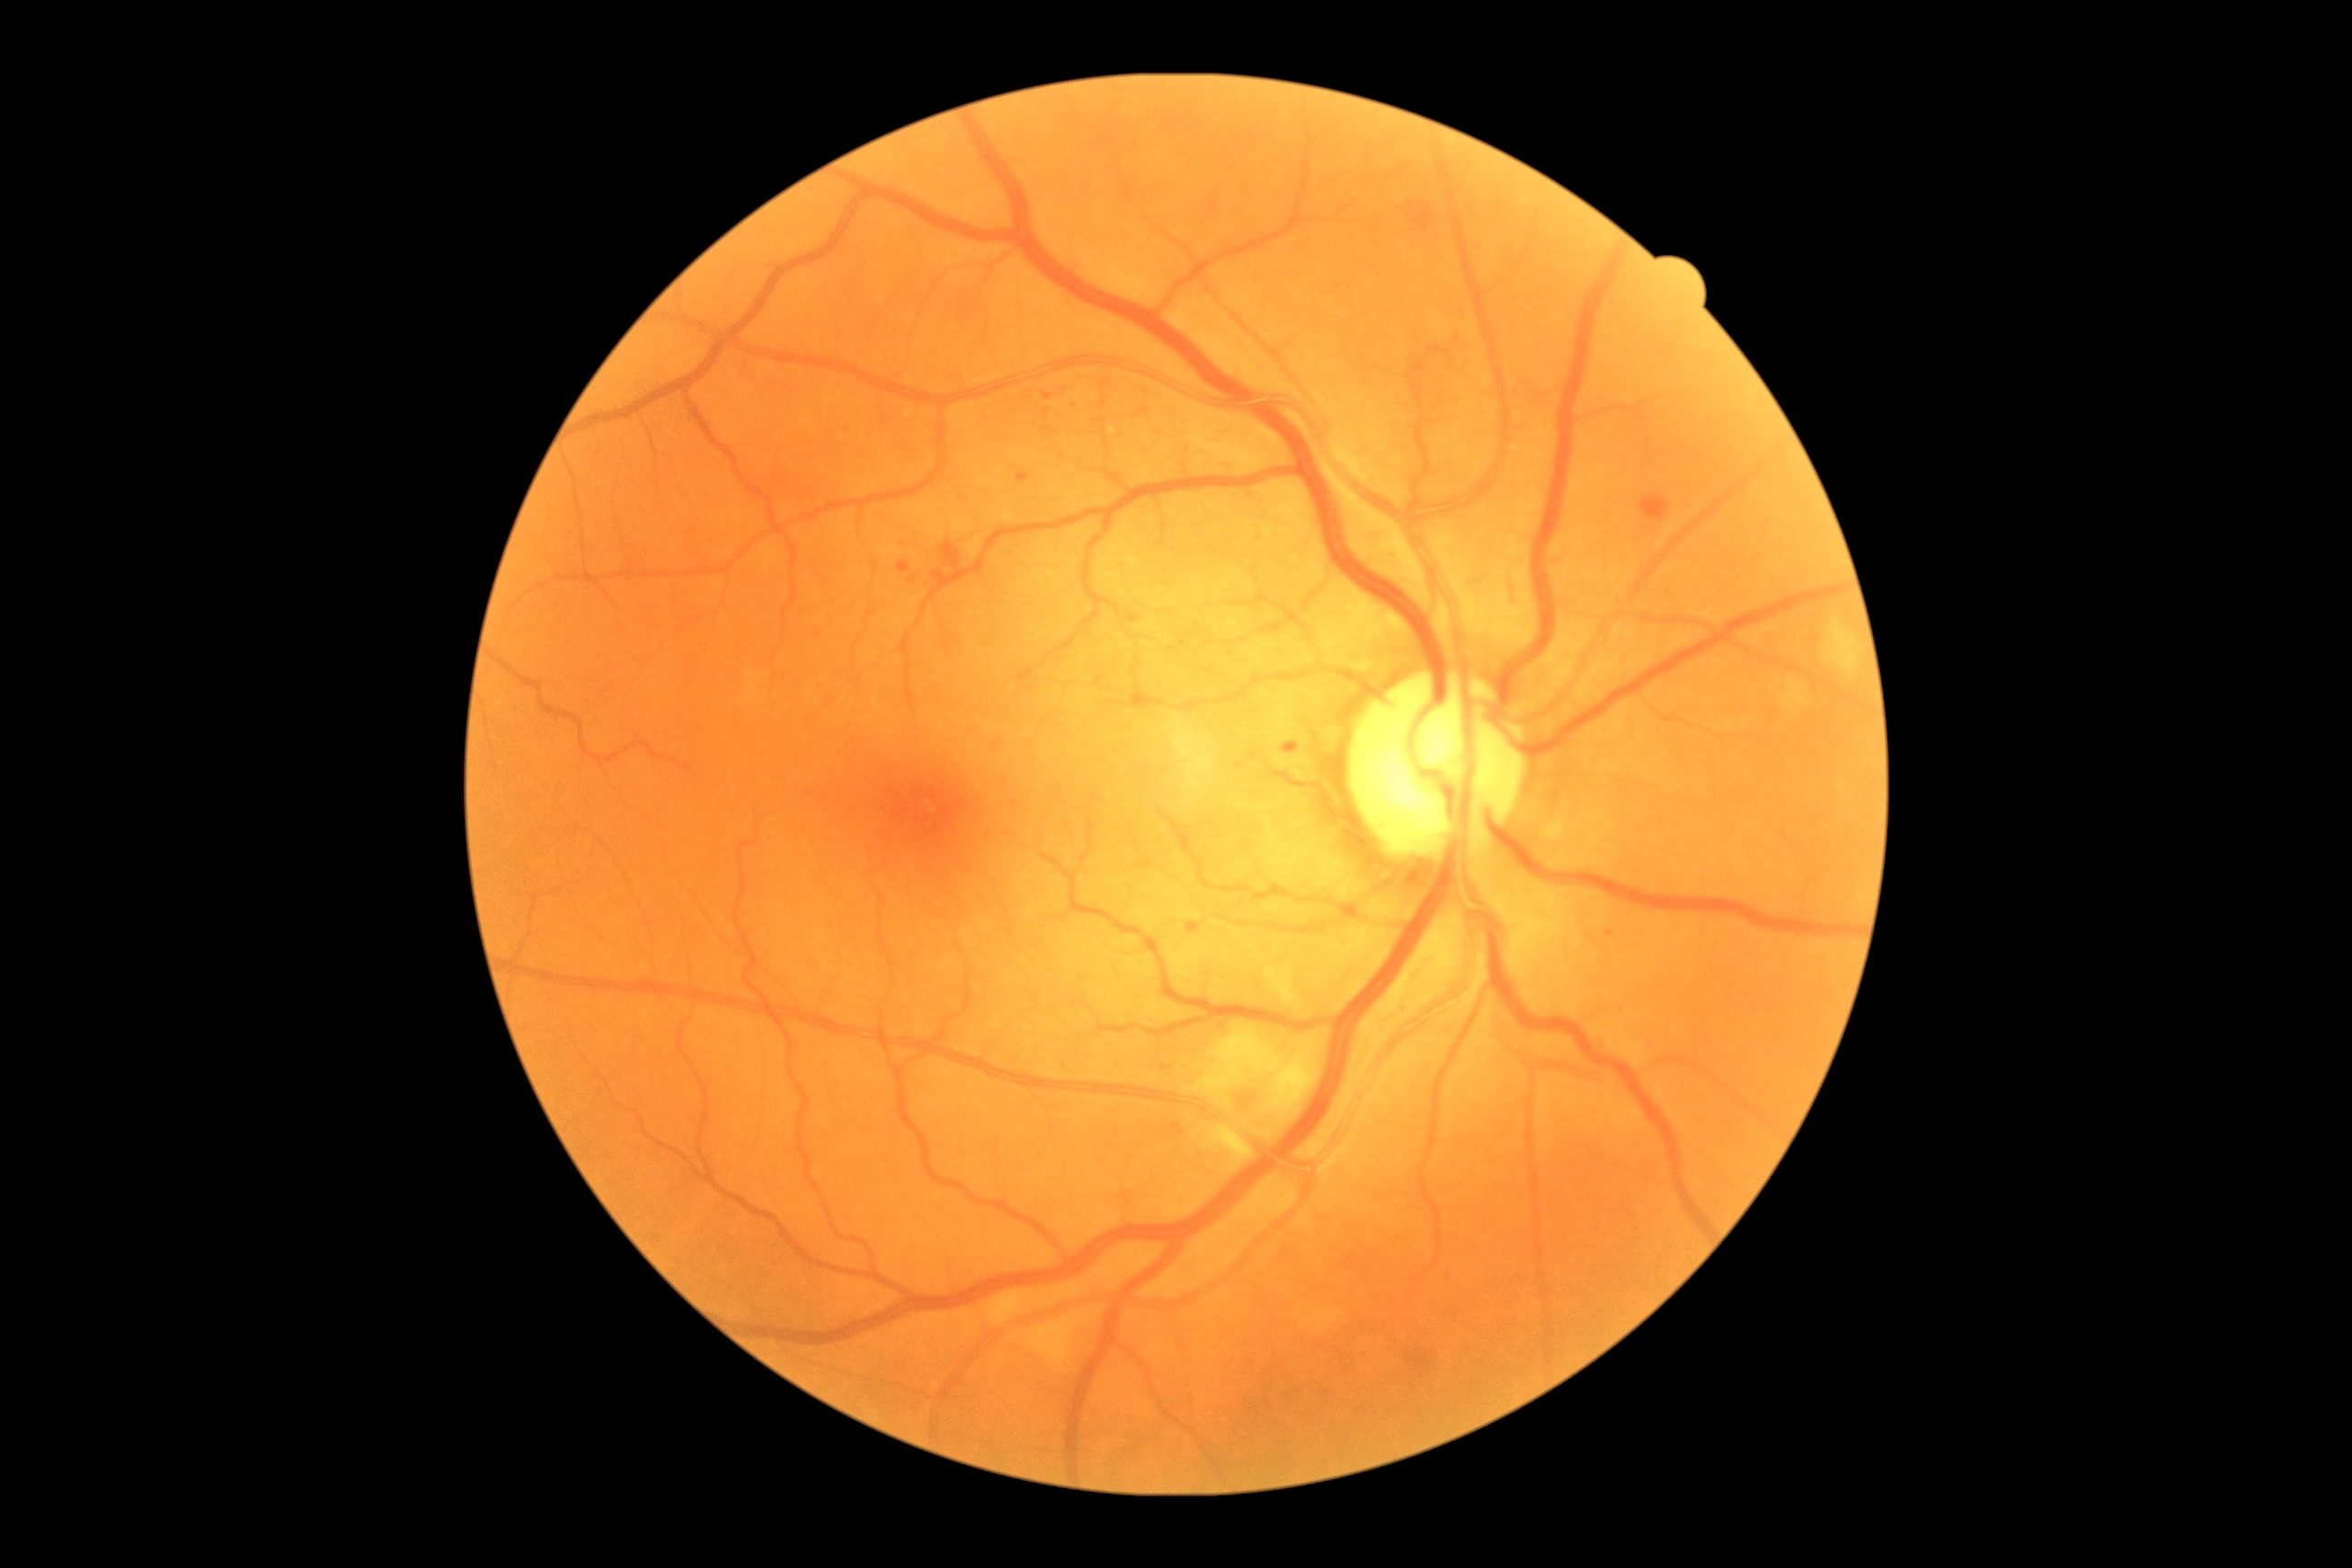 DR = 2.